Pediatric retinal photograph (wide-field) — 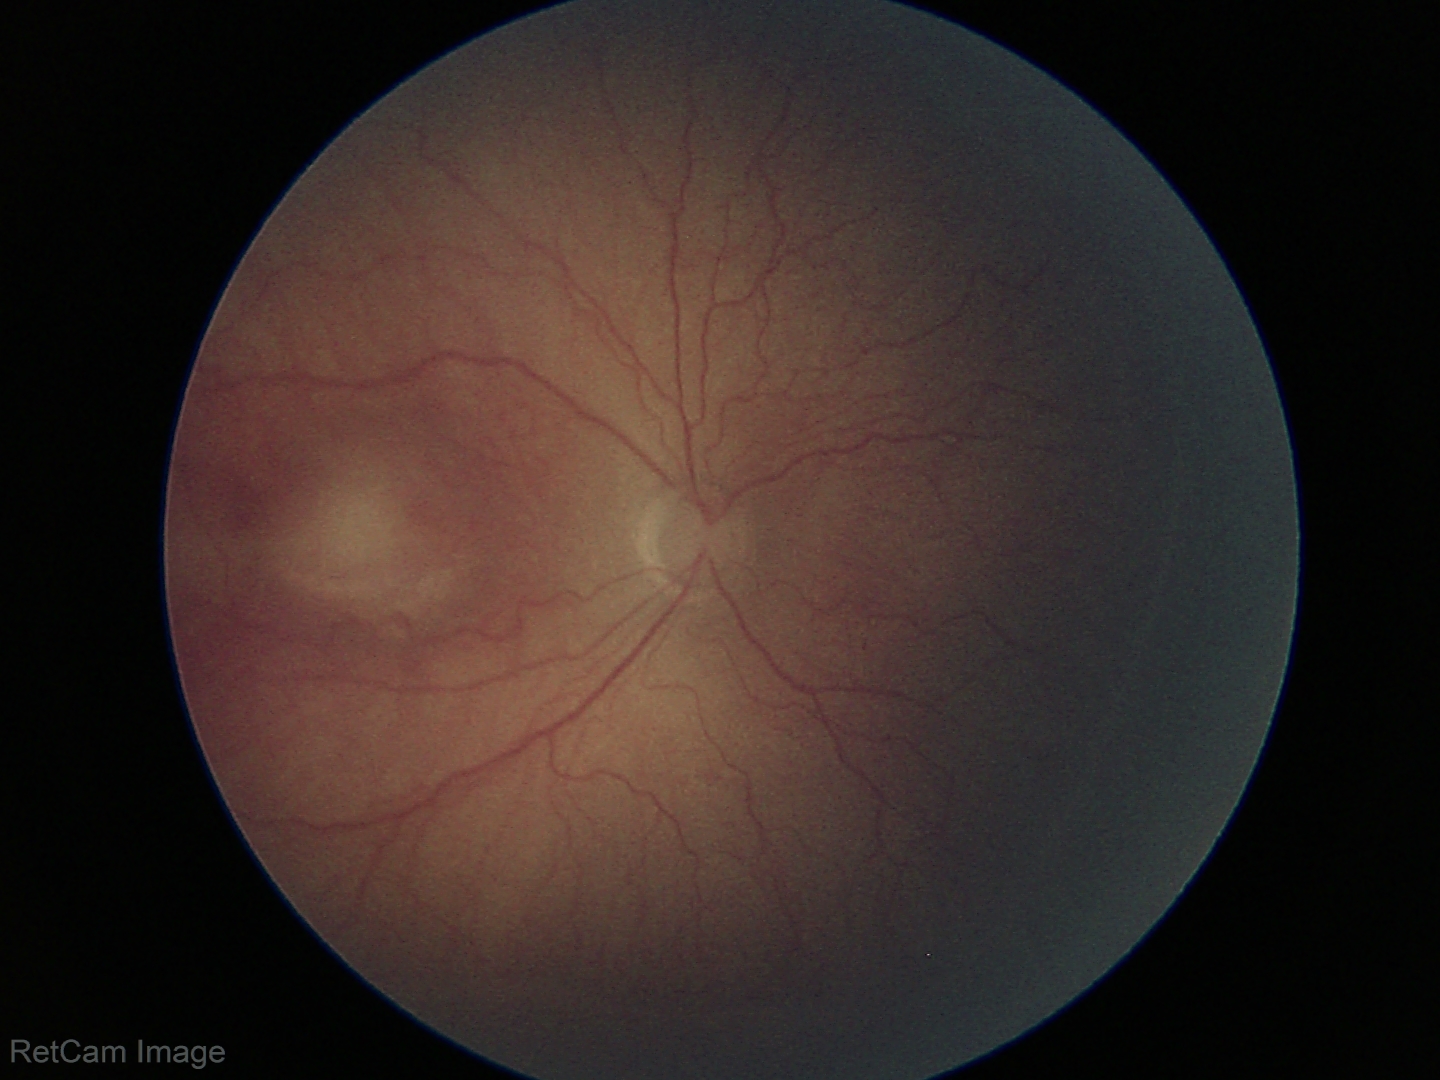
Screening series with retinopathy of prematurity (ROP) stage 2 — ridge with height and width at the demarcation line. Without plus disease.